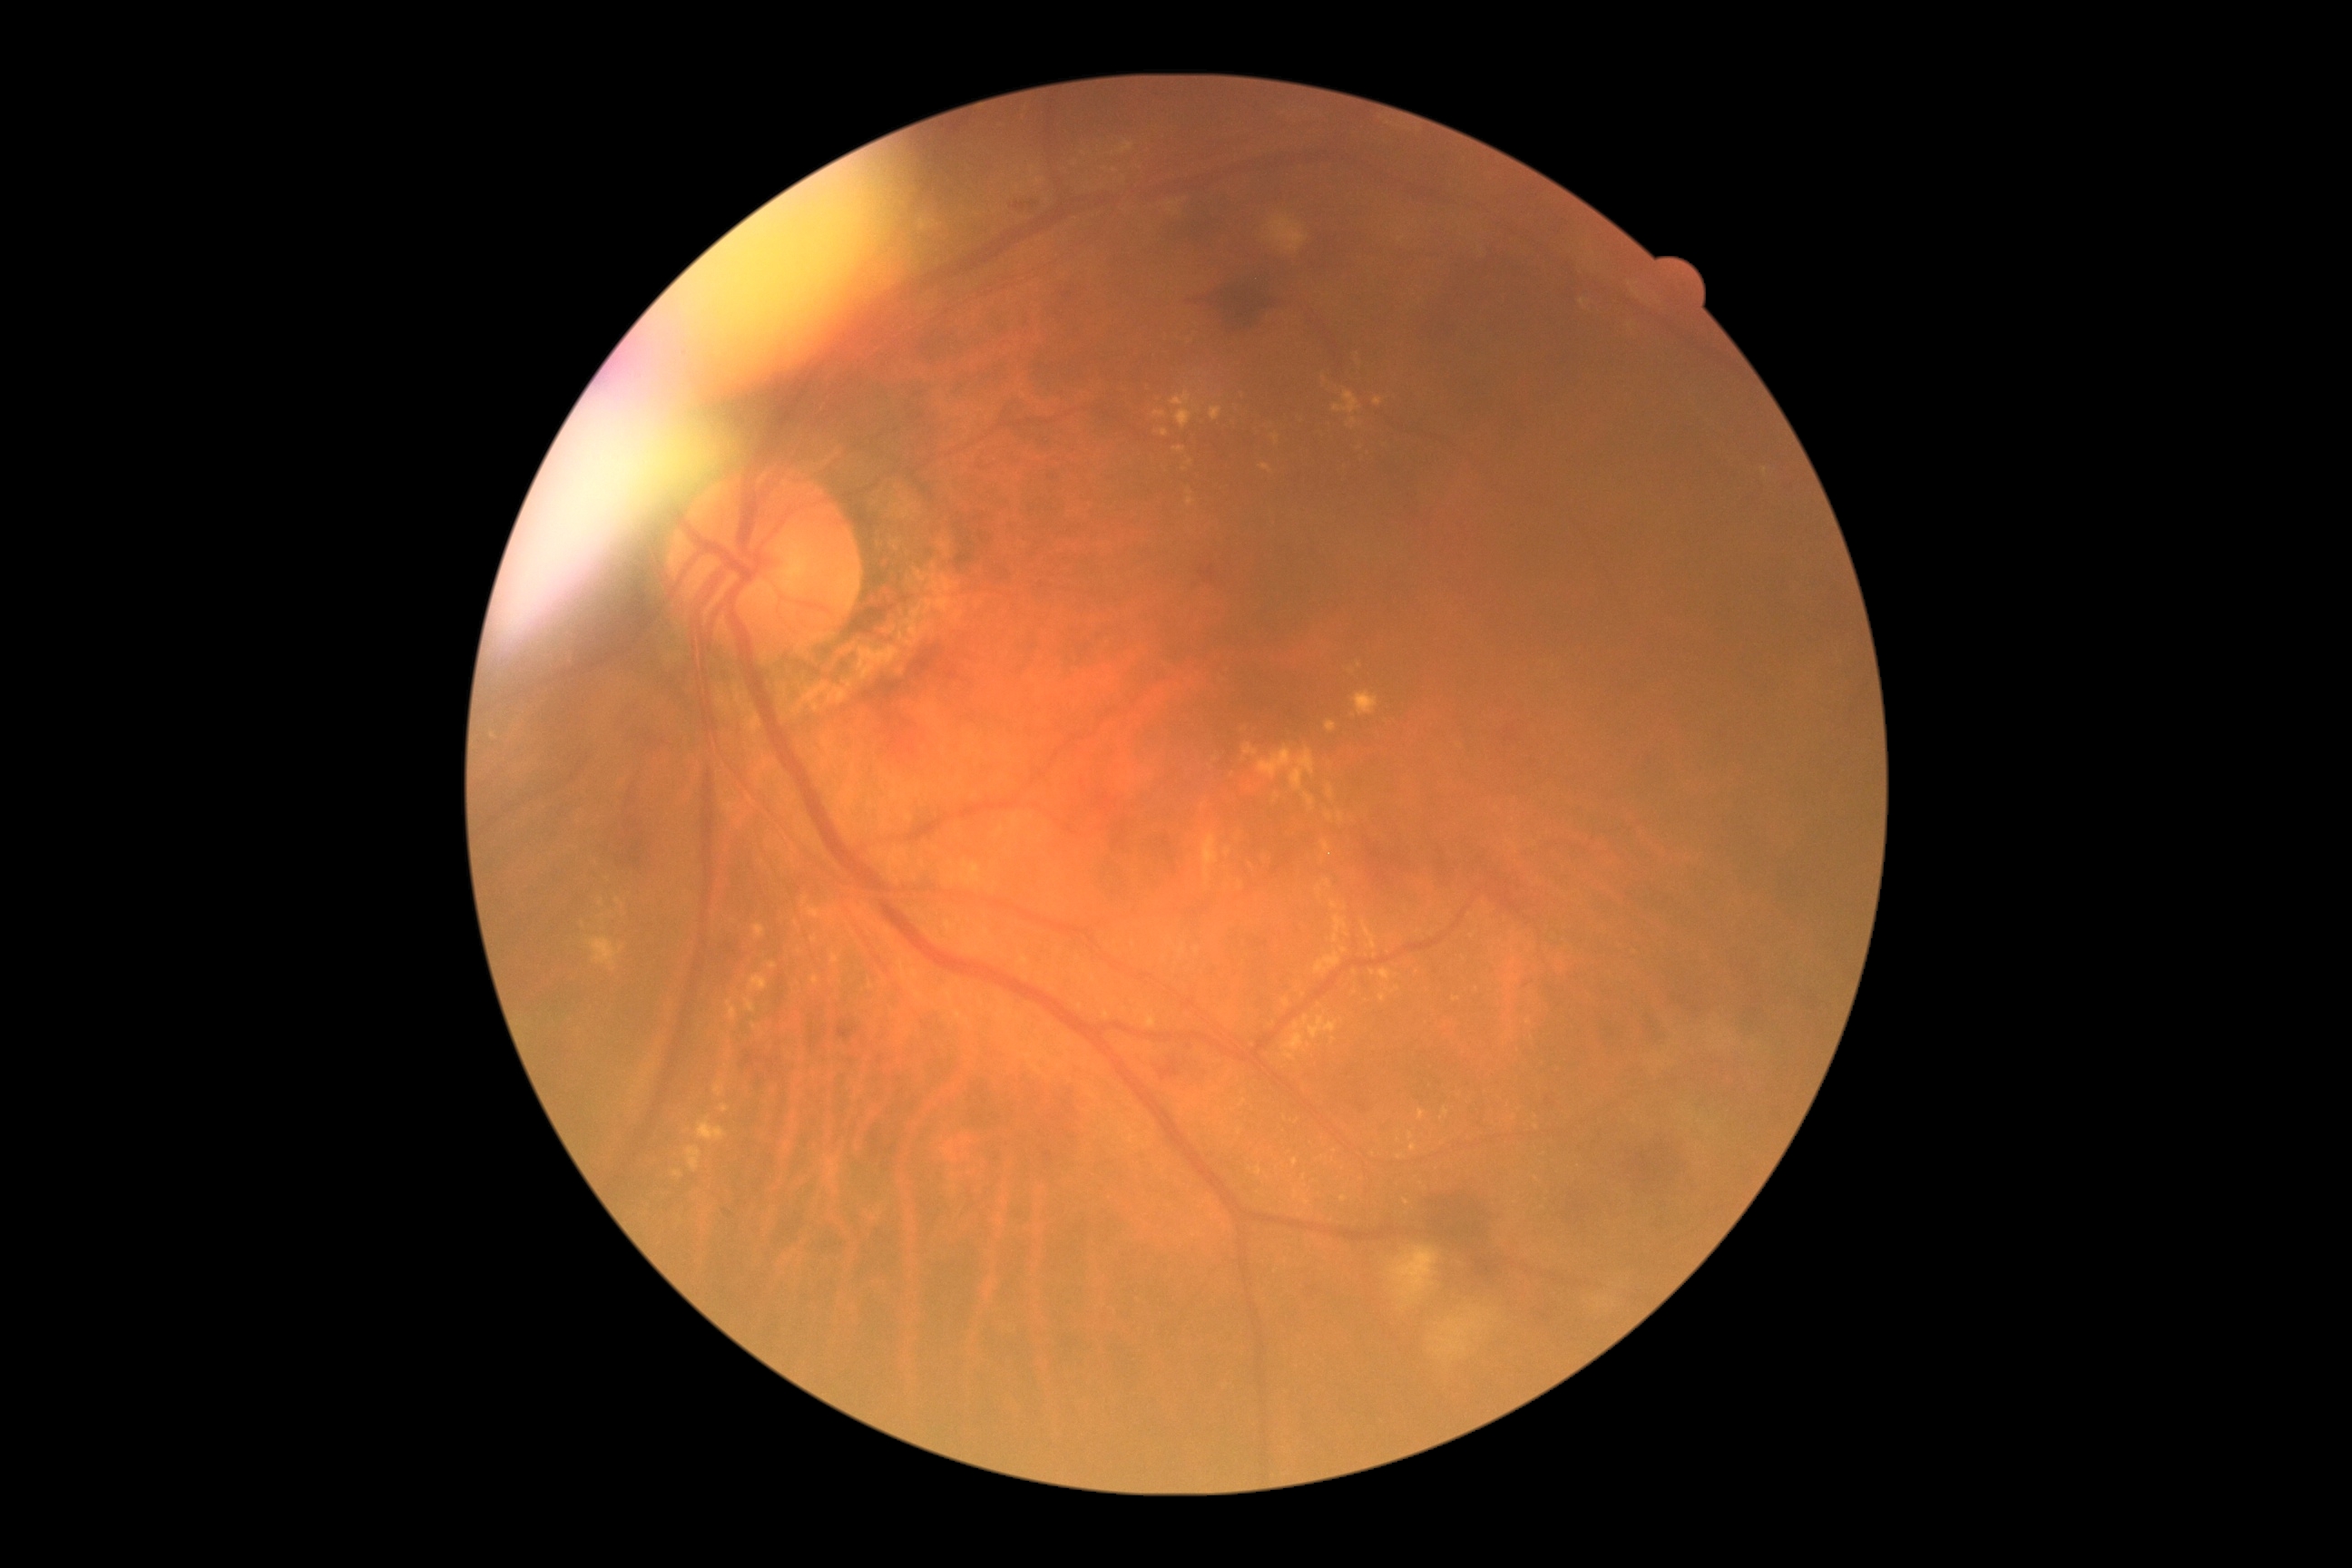
DR severity is grade 2 (moderate NPDR) — more than just microaneurysms but less than severe NPDR.